2352x1568px · 45° field of view · color fundus image:
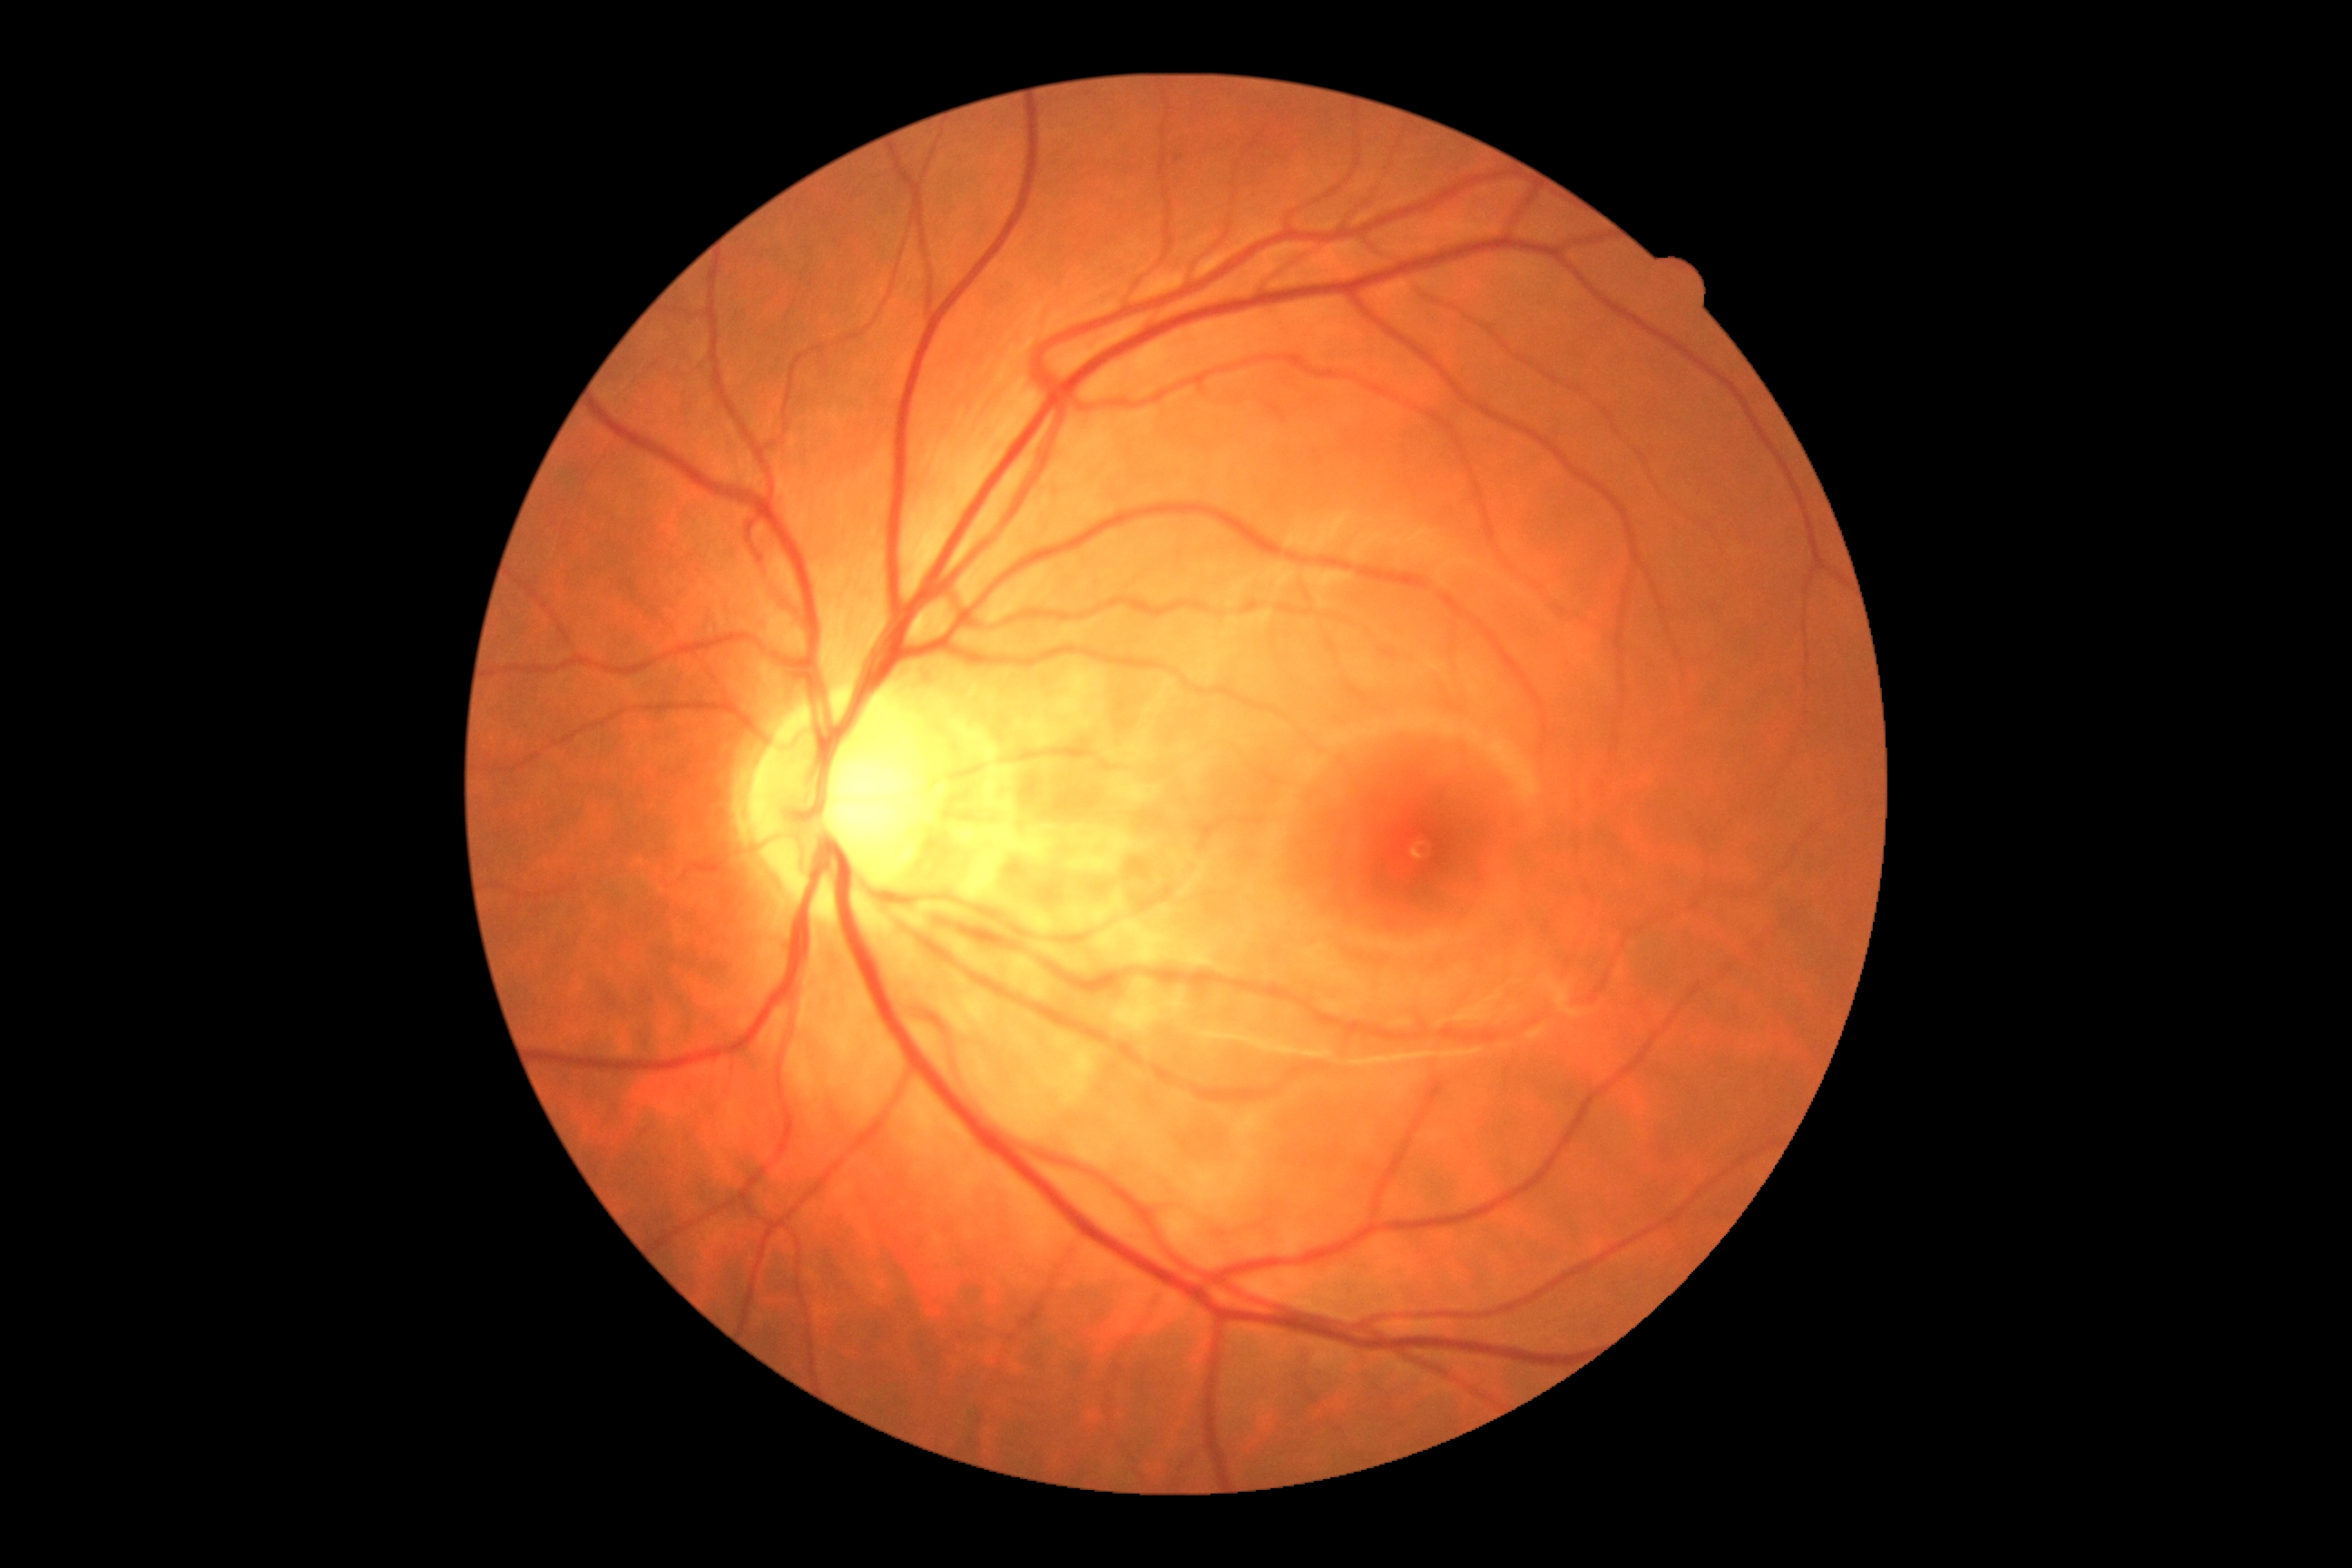

DR severity: no apparent diabetic retinopathy (grade 0) — no visible signs of diabetic retinopathy.